DR severity per modified Davis staging — 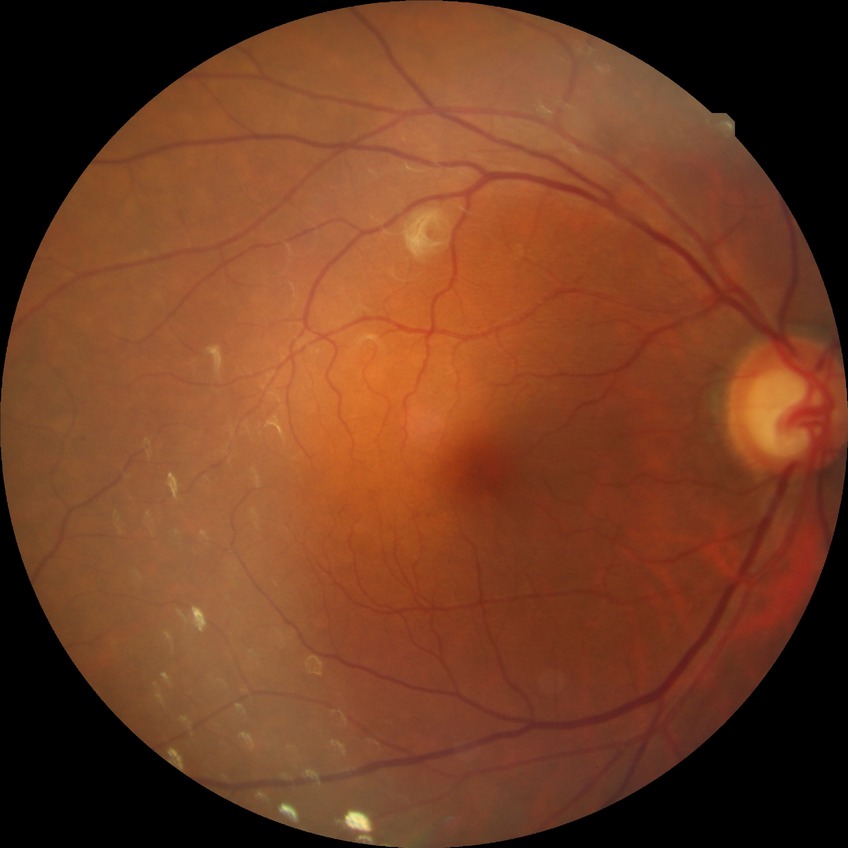

Modified Davis grading: no diabetic retinopathy.